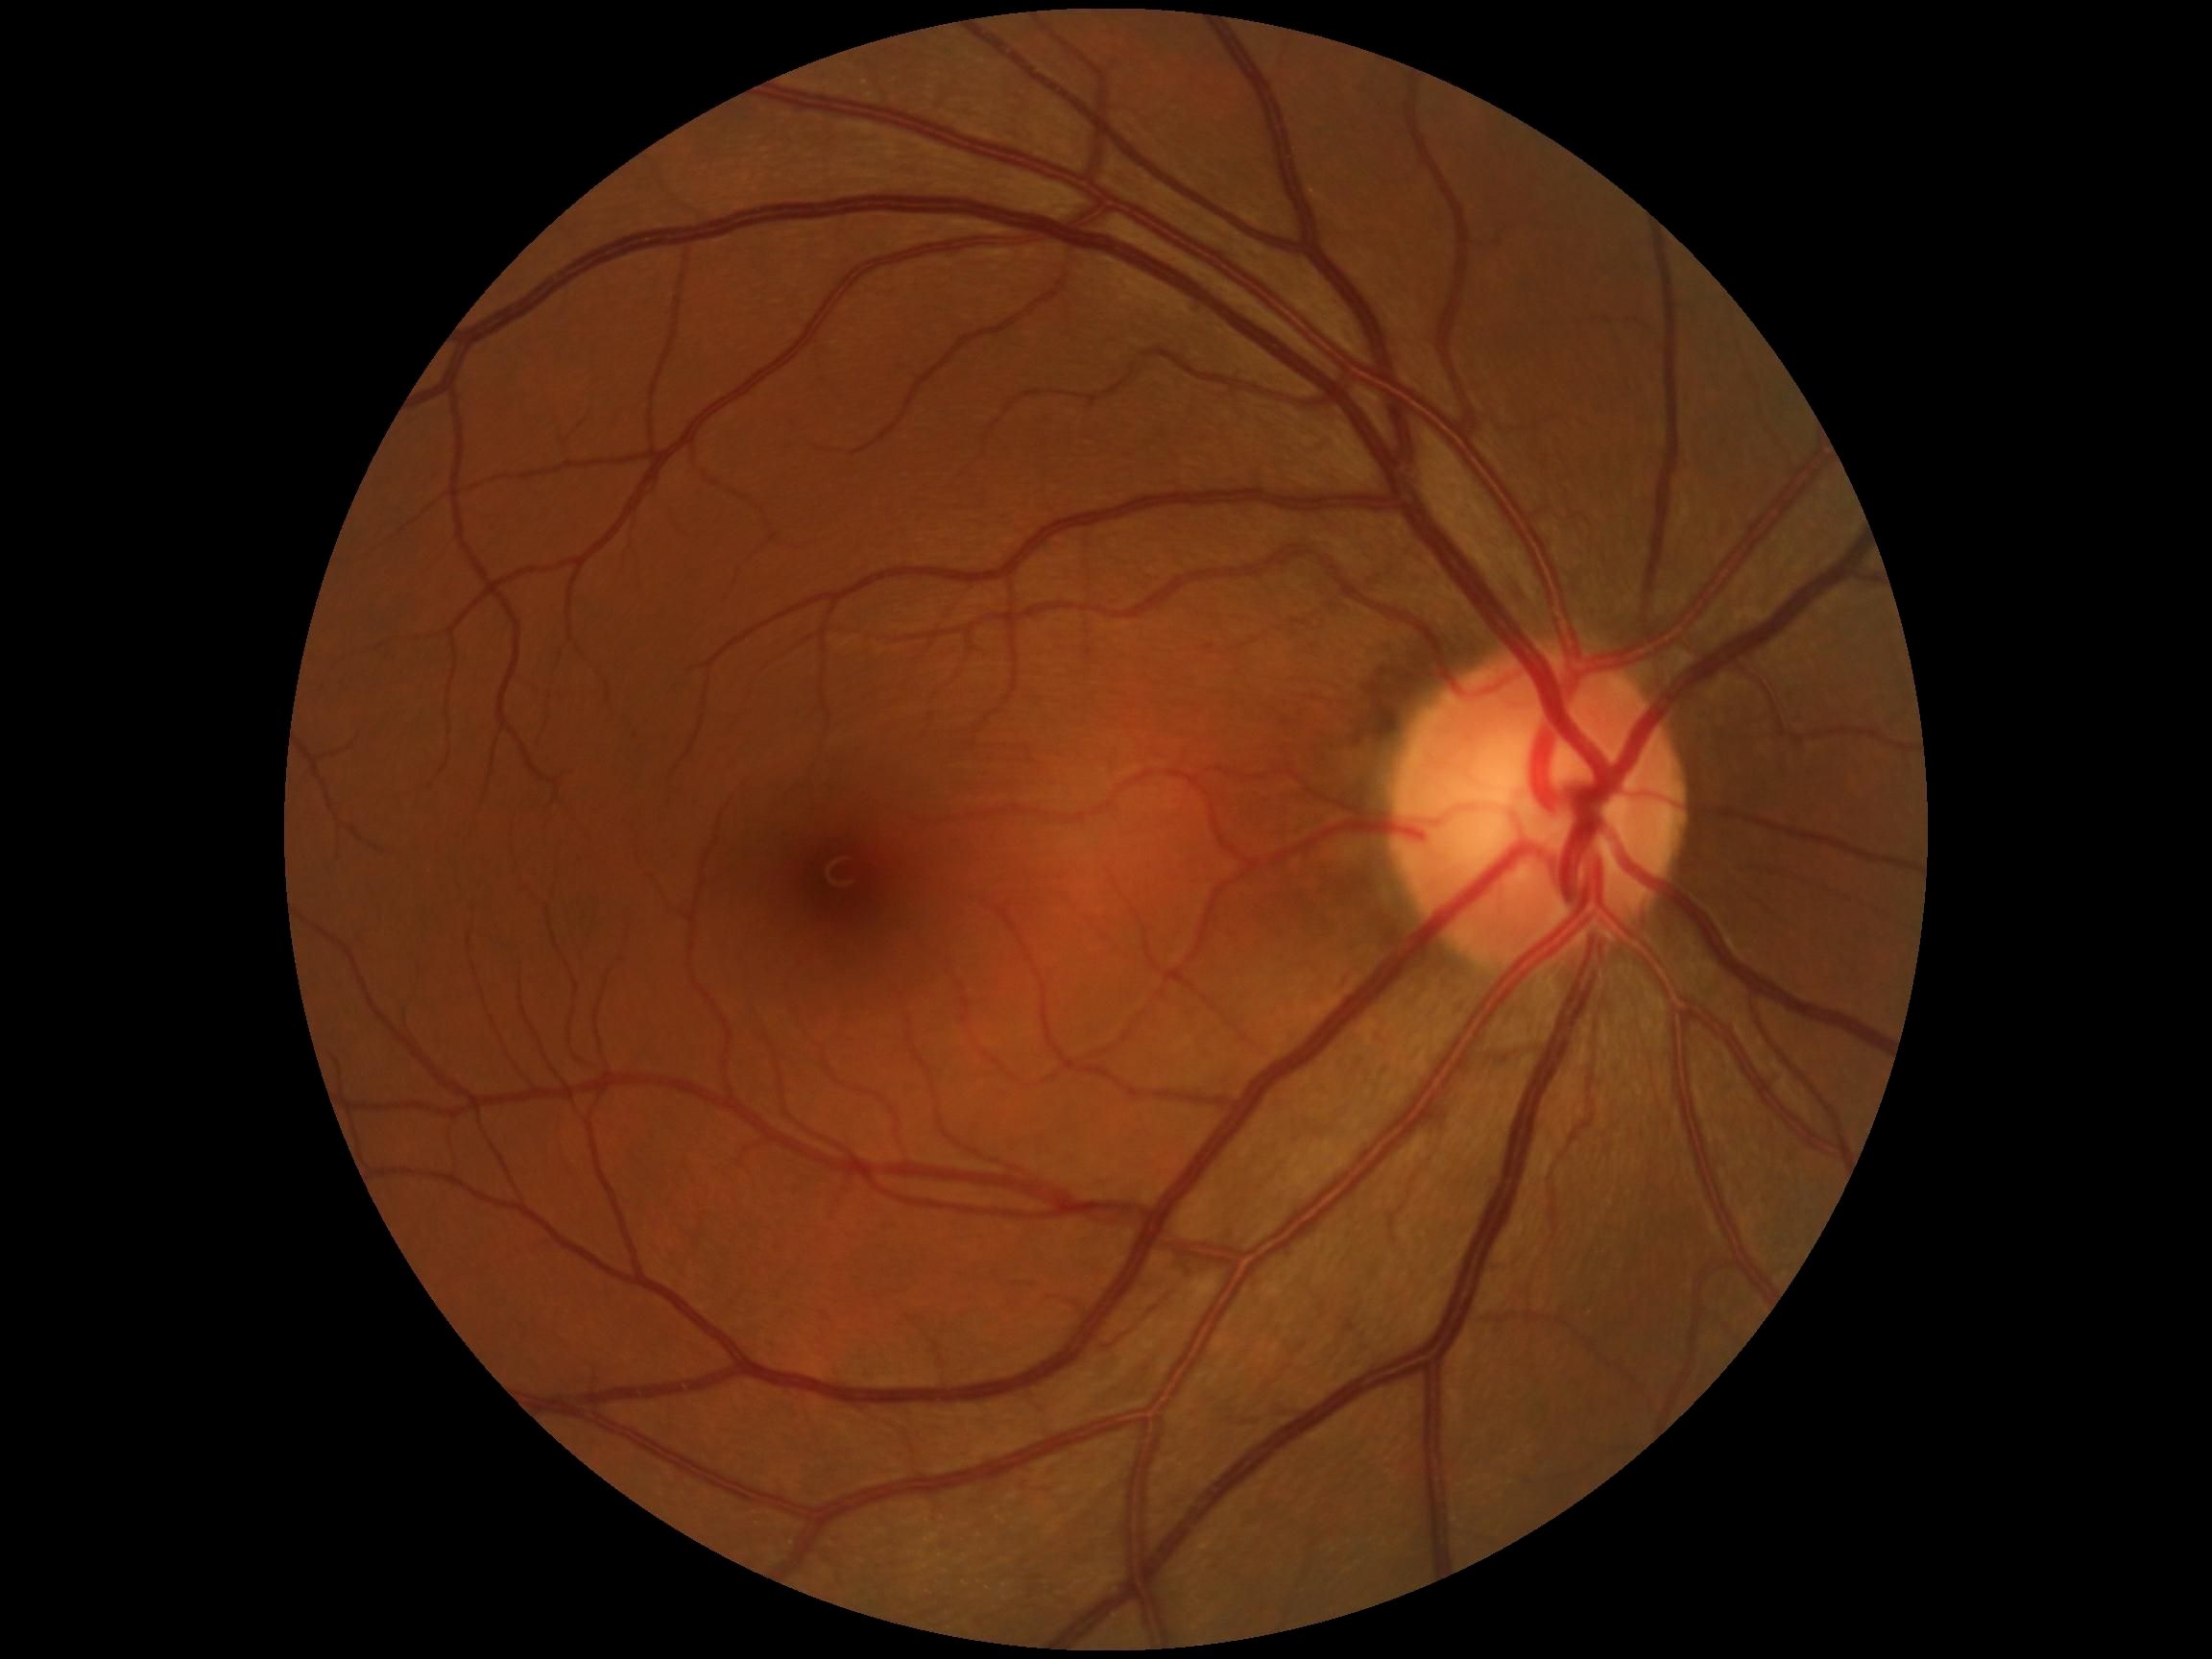 dr_impression: no signs of DR
dr_grade: no apparent diabetic retinopathy (0)